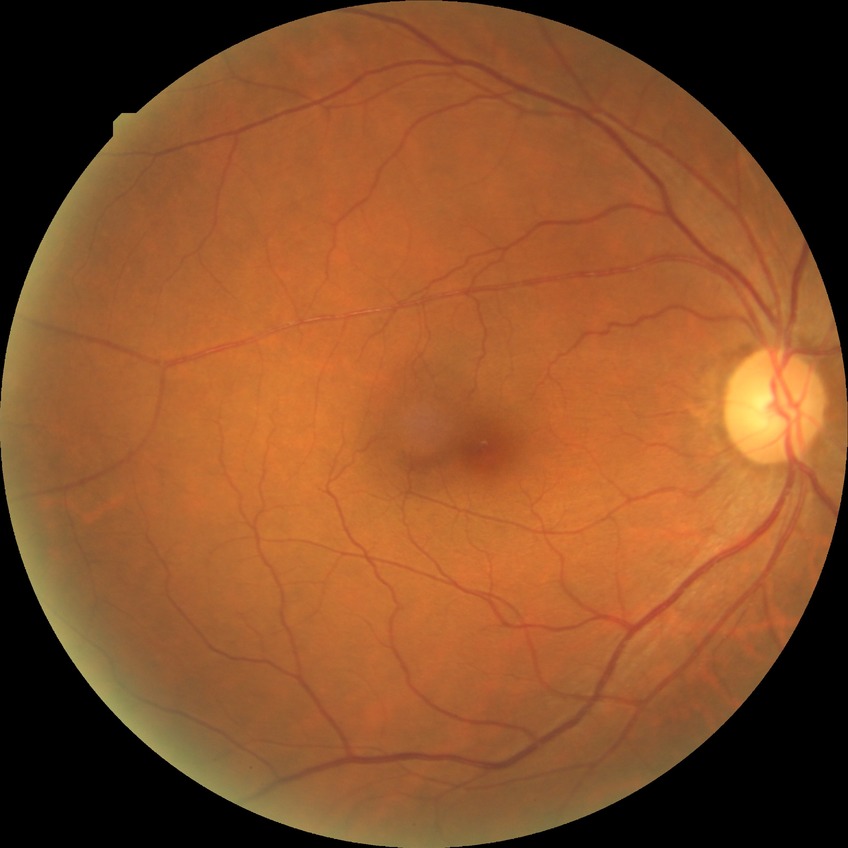

{"davis_grade": "simple diabetic retinopathy (SDR)"}